Infant wide-field retinal image. 640x480px: 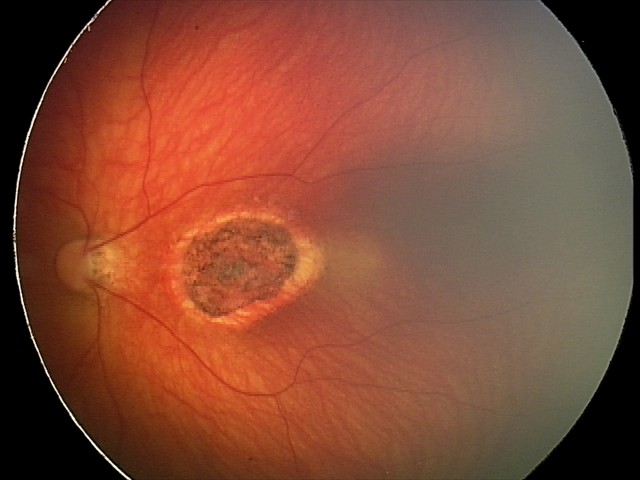
Screening series with toxoplasmosis chorioretinitis.